Infant wide-field fundus photograph · image size 640x480 · Clarity RetCam 3, 130° FOV
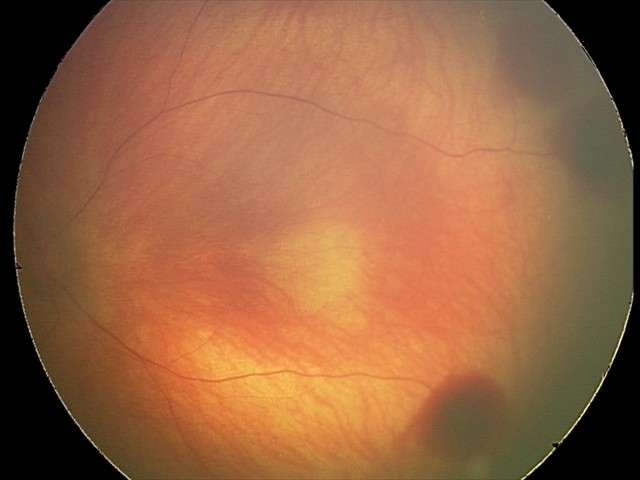 Screening series with retinal hemorrhages.